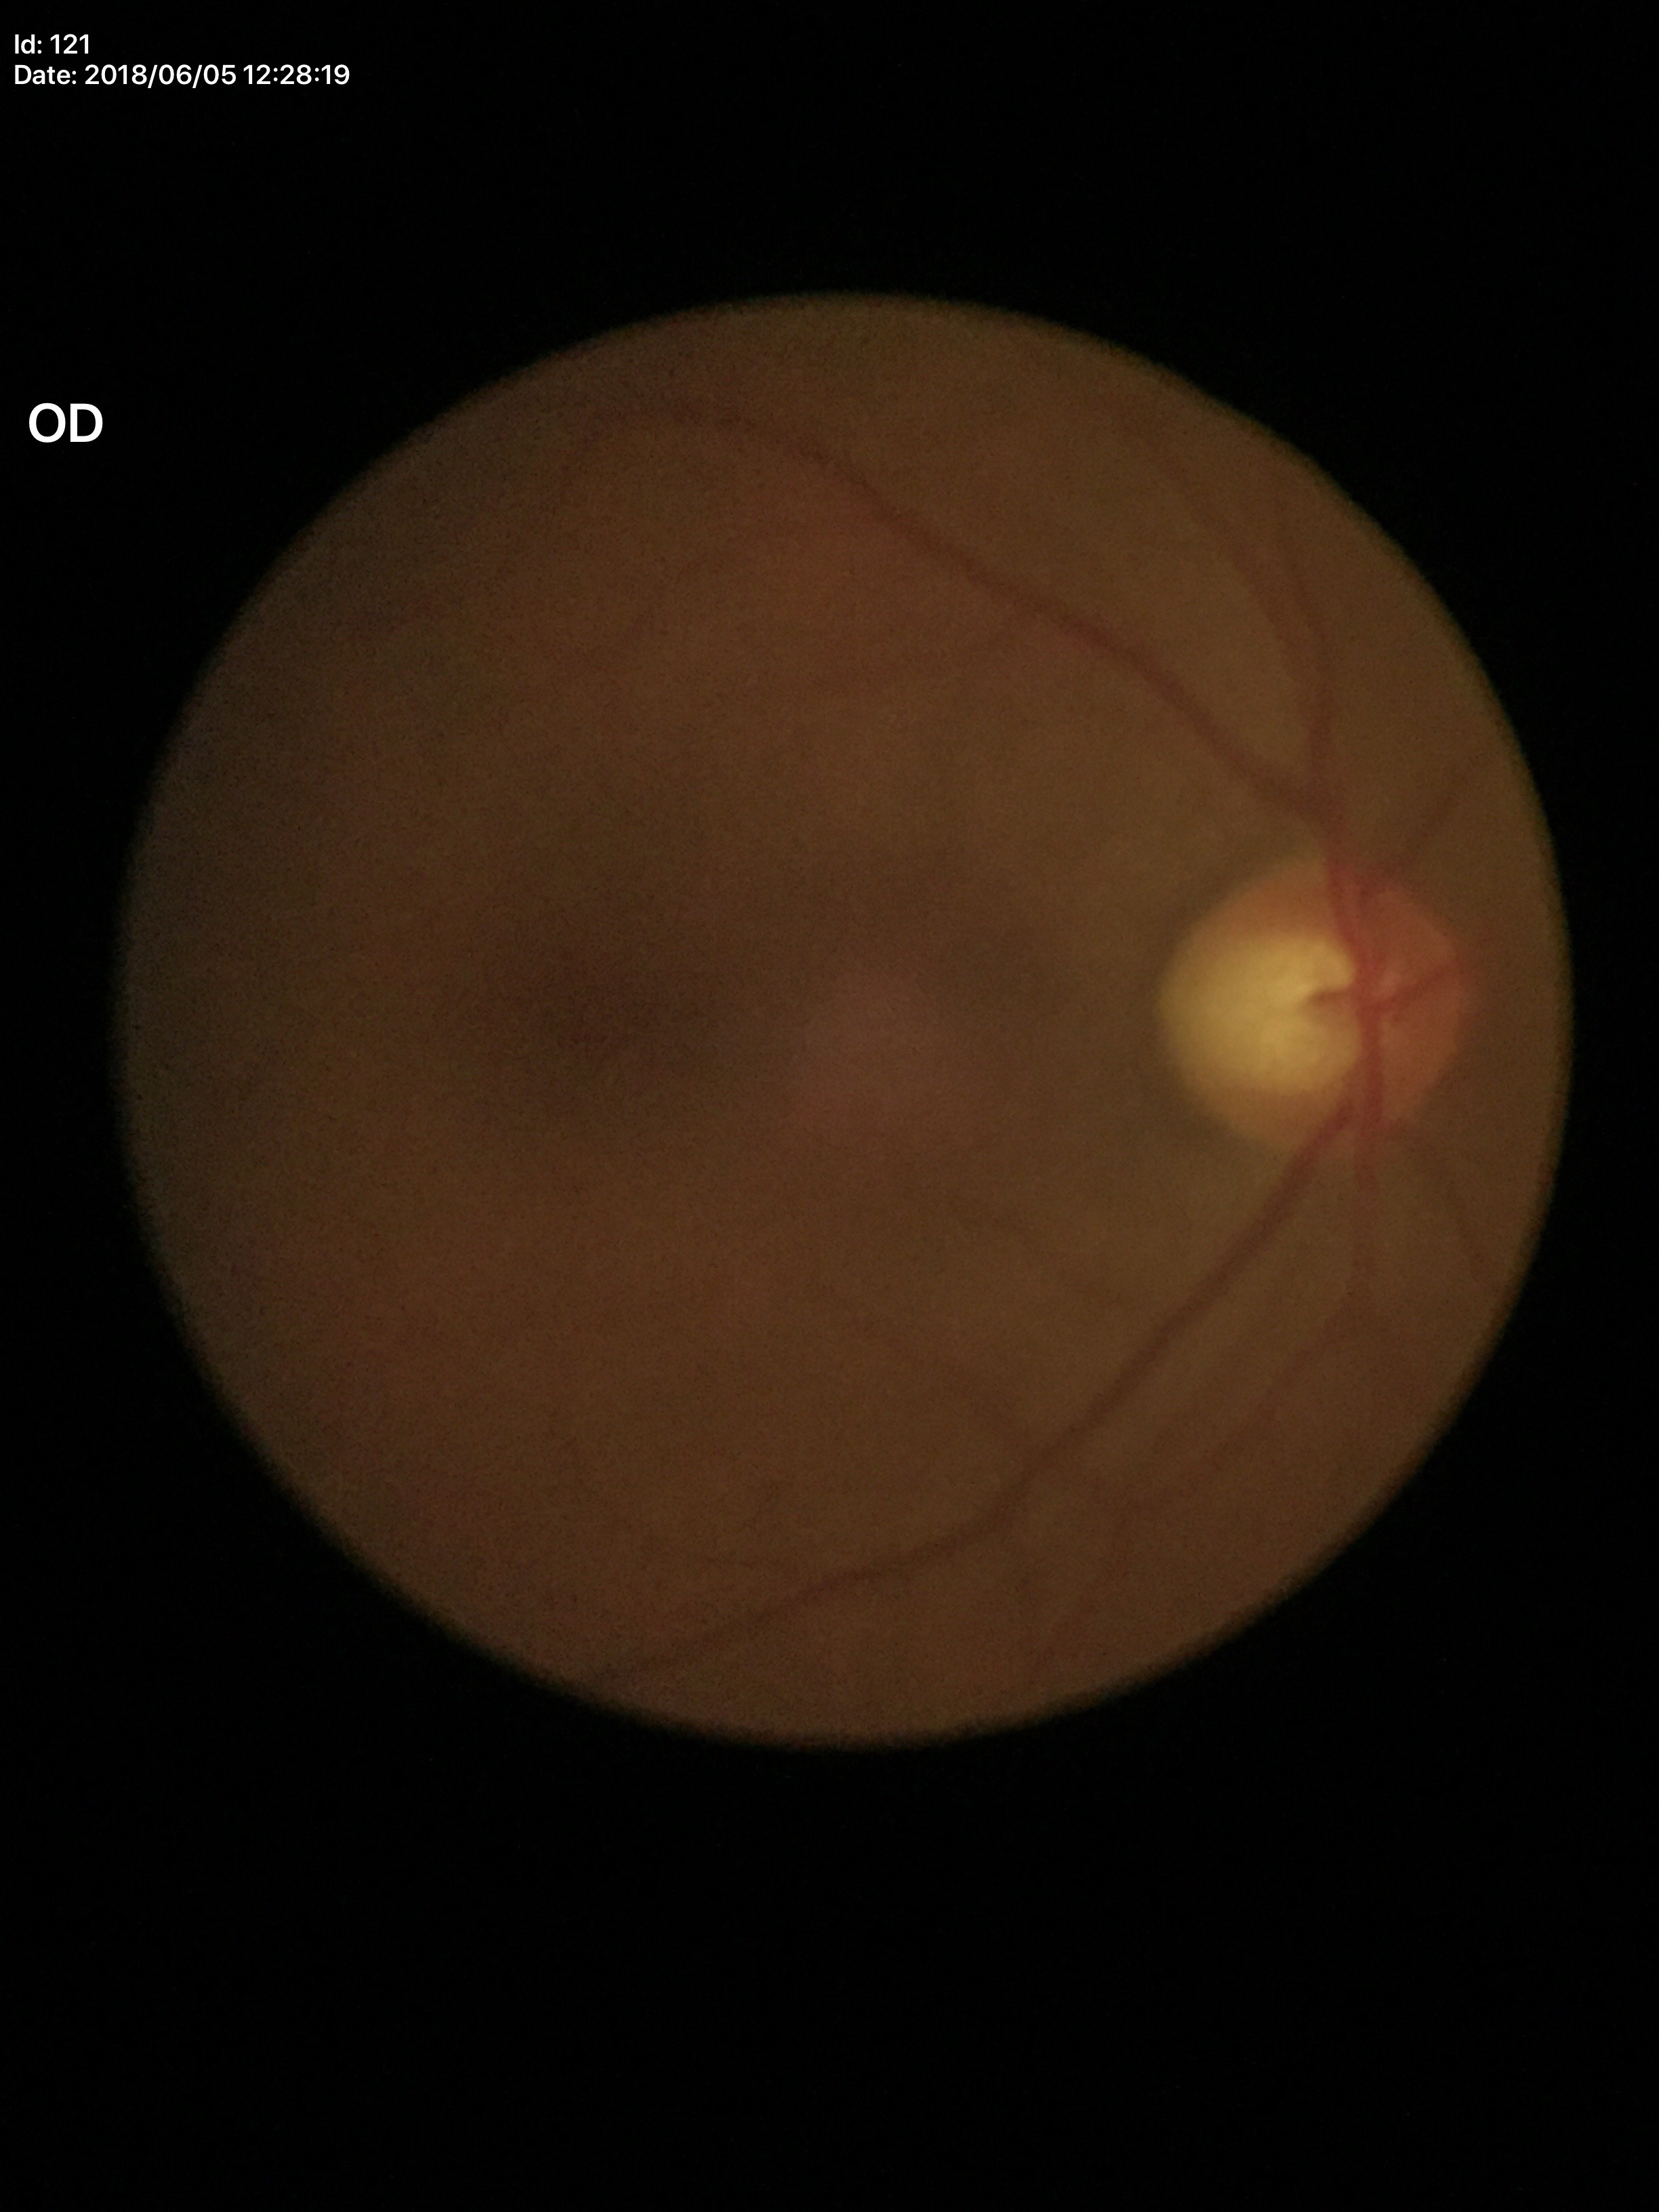

Q: What is the glaucoma assessment?
A: suspect (four of five ophthalmologists flagged glaucoma suspect)
Q: Vertical CDR?
A: 0.60